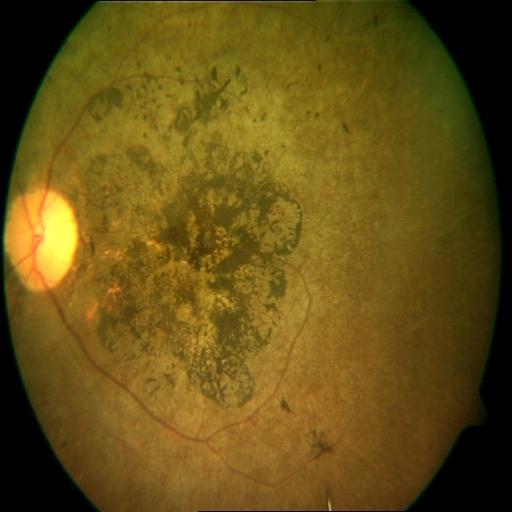

Diagnoses: retinitis pigmentosa.